1240x1240. Pediatric wide-field fundus photograph. Acquired on the Phoenix ICON:
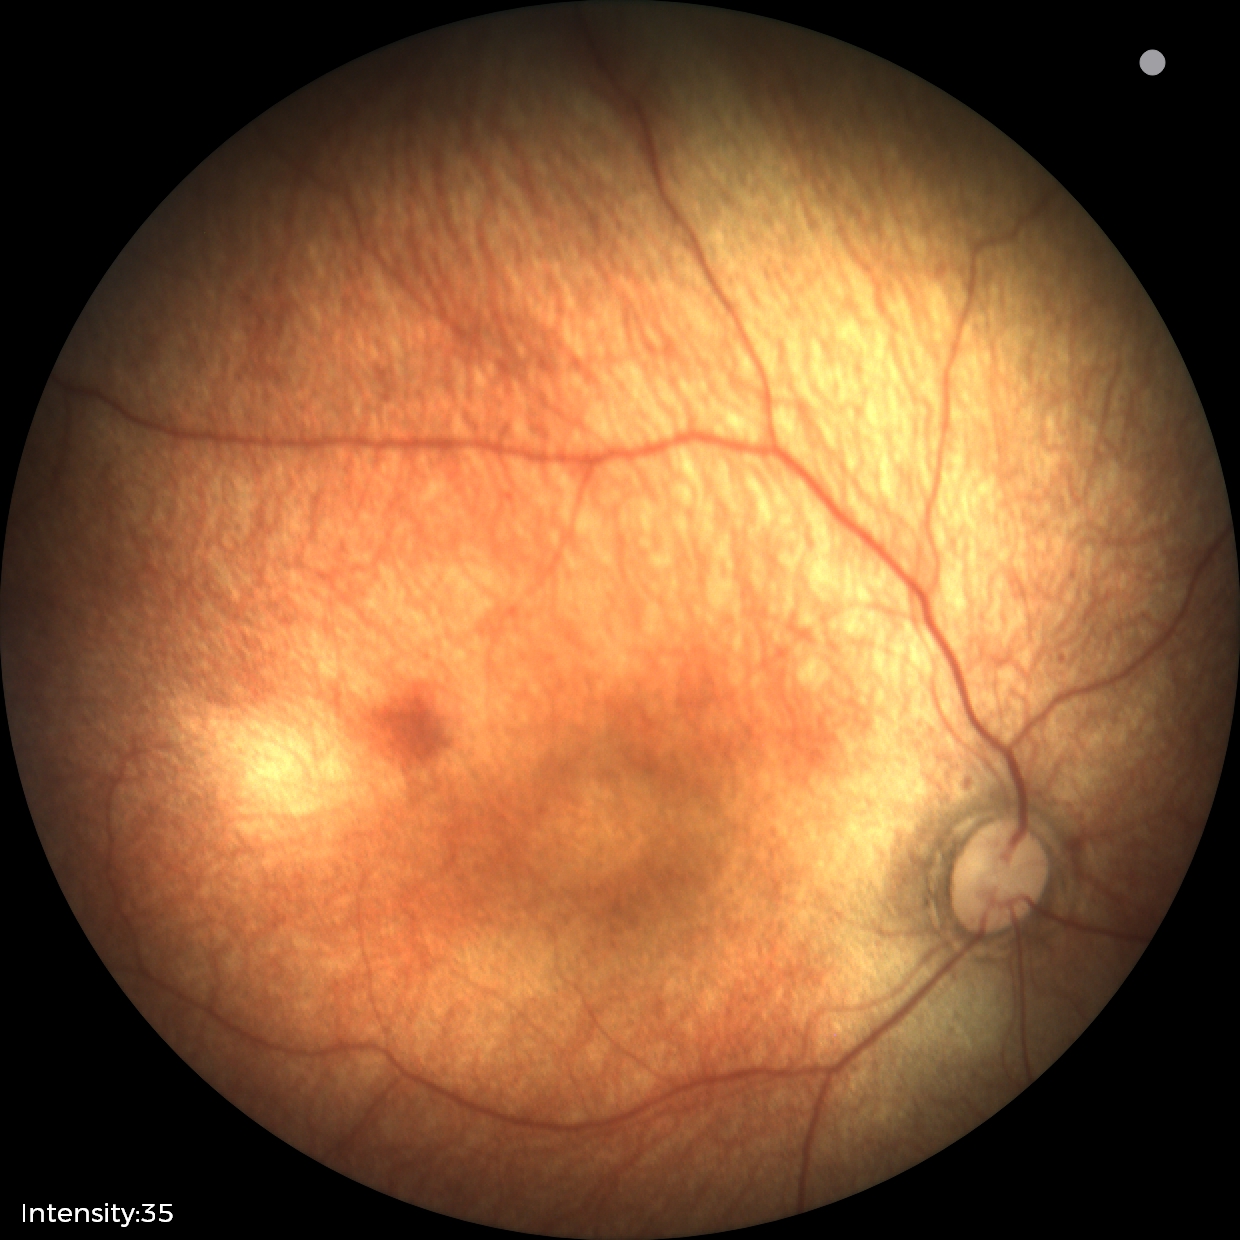 Diagnosis: physiological appearance.